130° field of view (Clarity RetCam 3); wide-field fundus photograph from neonatal ROP screening
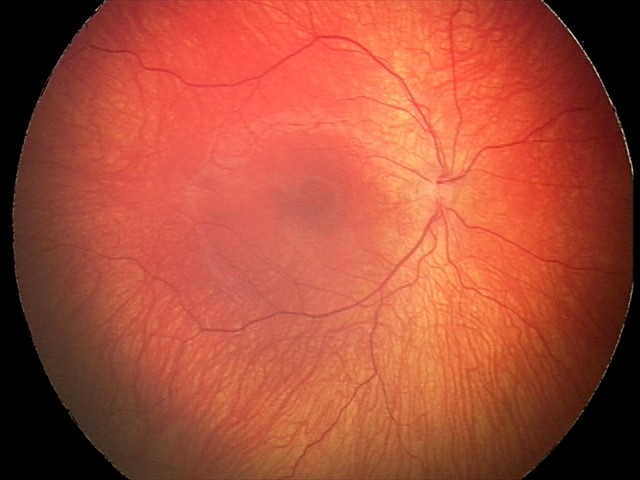 Impression: status post ROP